Ultra-widefield fundus photograph; 200° FOV:
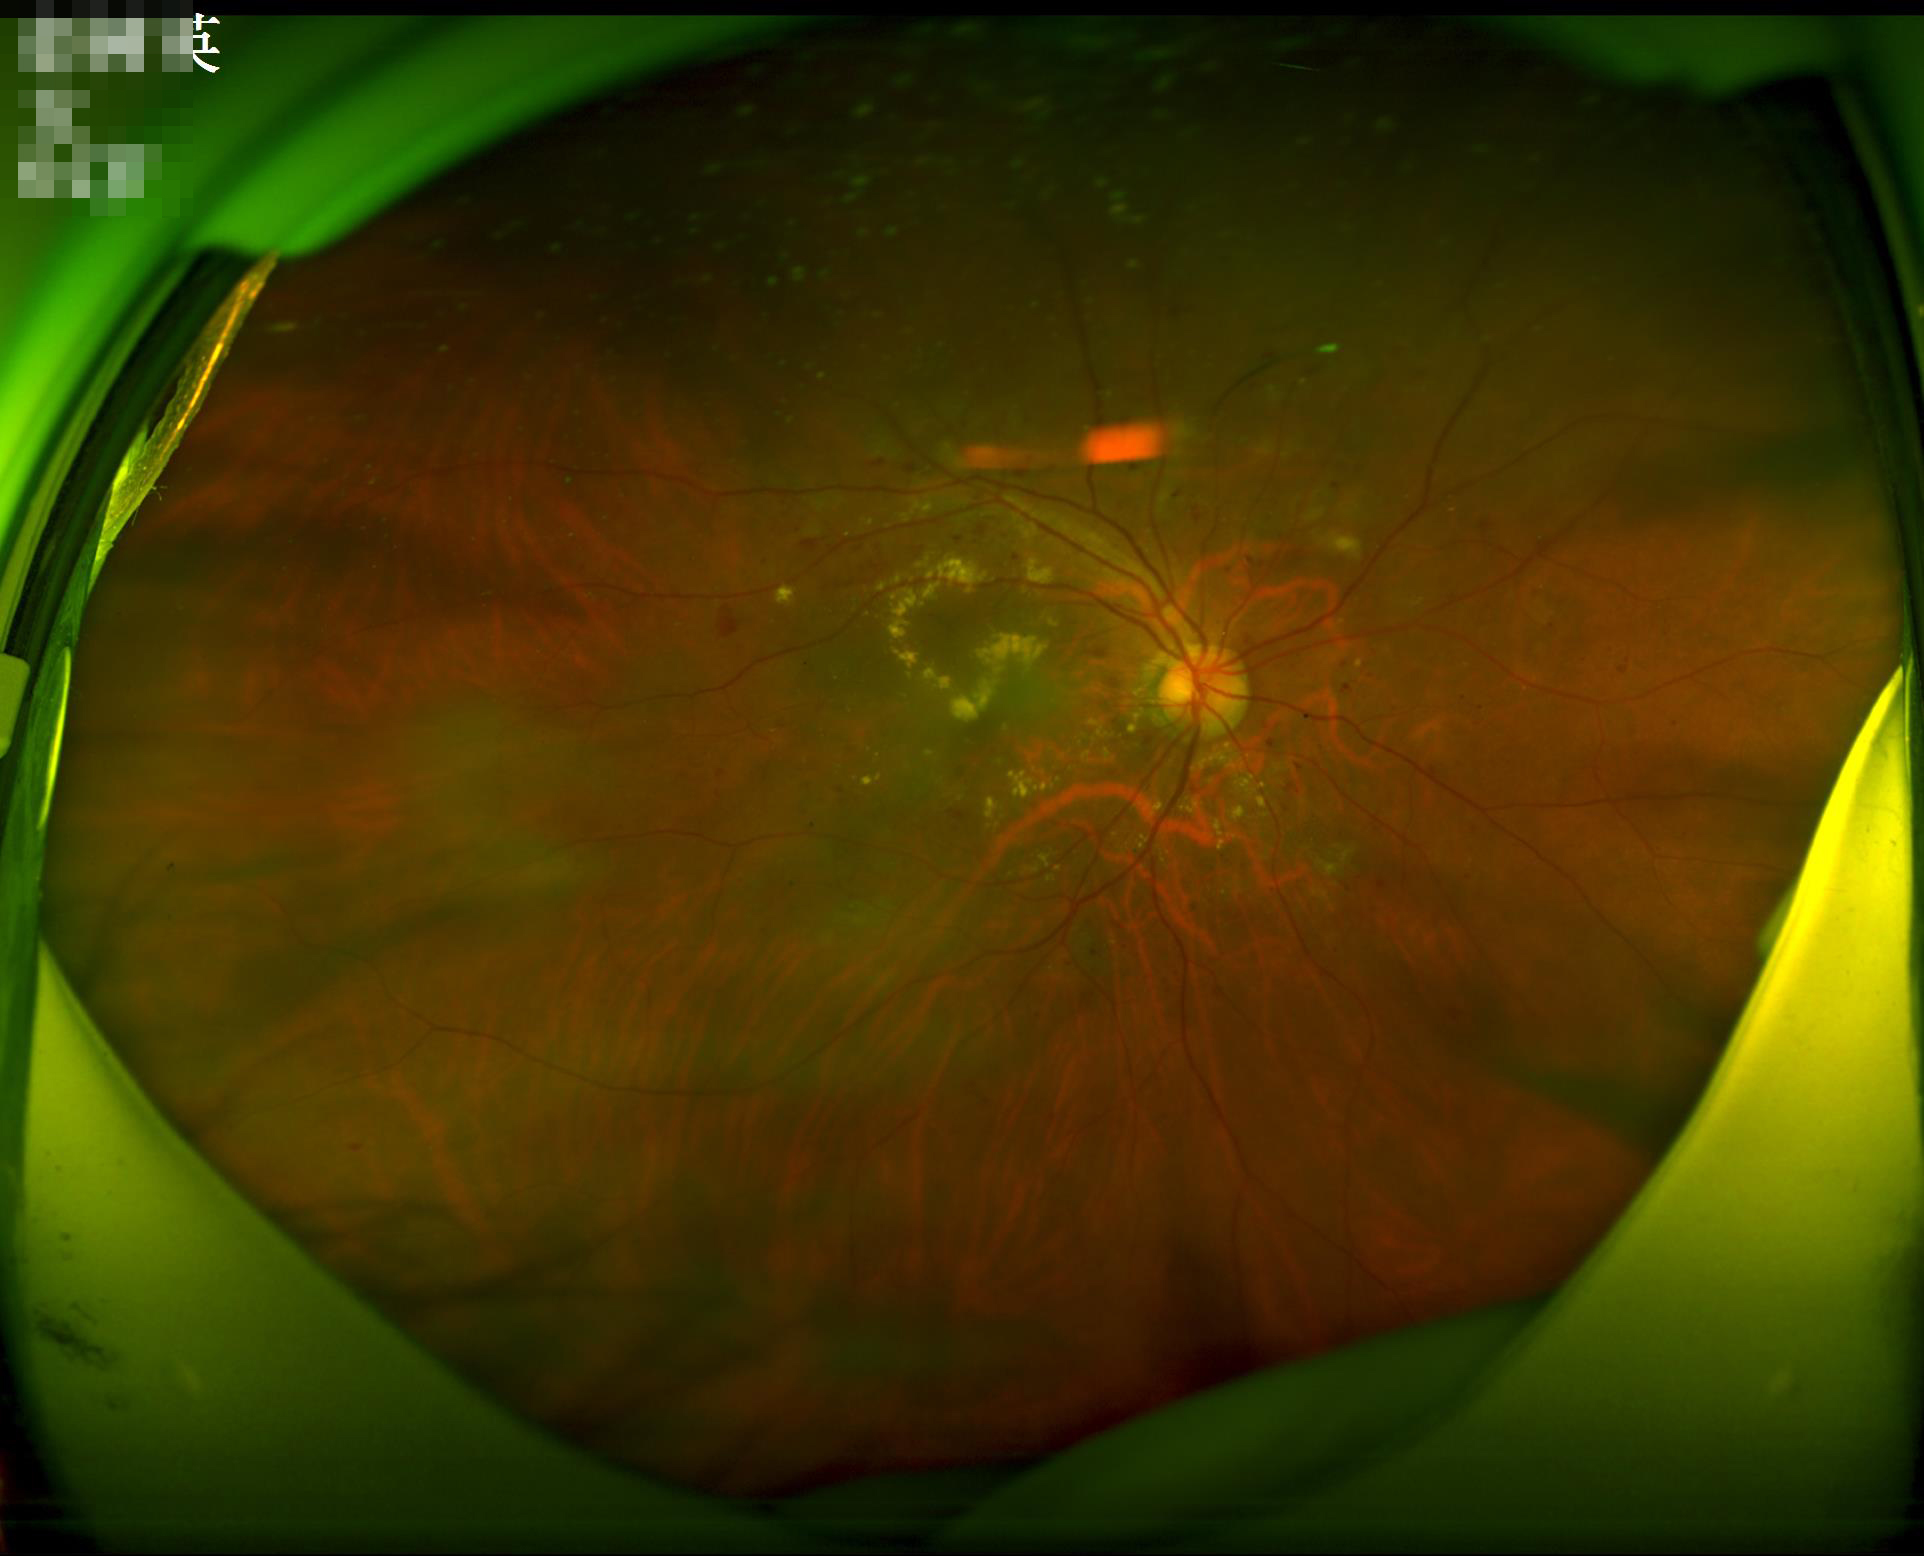
No over- or under-exposure.
Adequate contrast for distinguishing structures.
Overall image quality is good.